NIDEK AFC-230 fundus camera, no pharmacologic dilation — 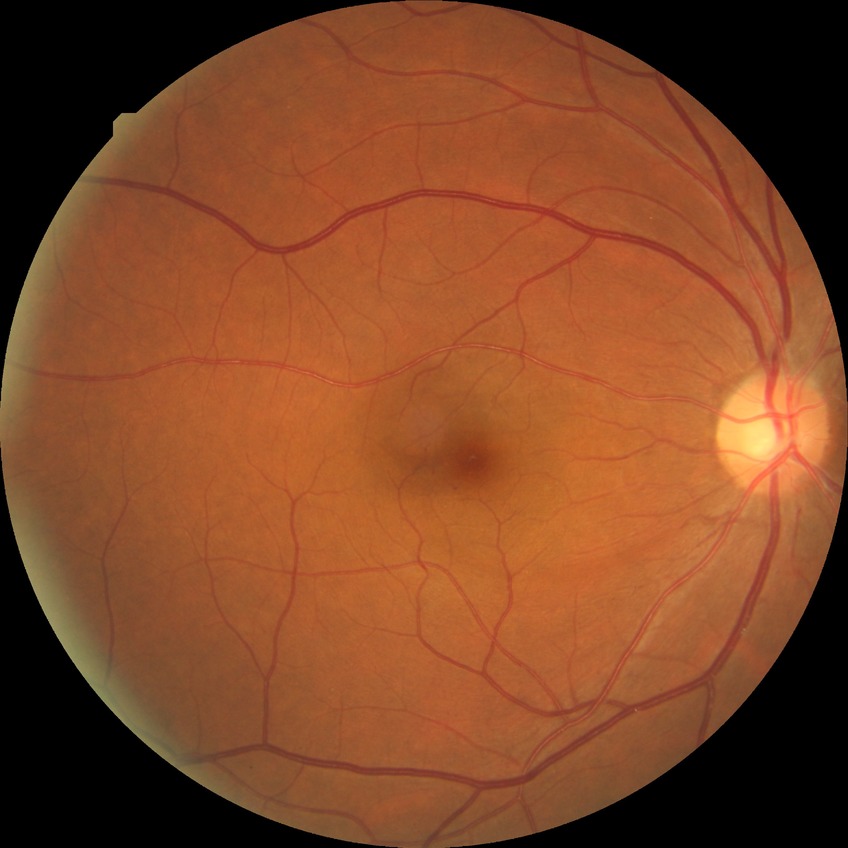
diabetic retinopathy severity@simple diabetic retinopathy.